2212x1659 · FOV: 45 degrees: 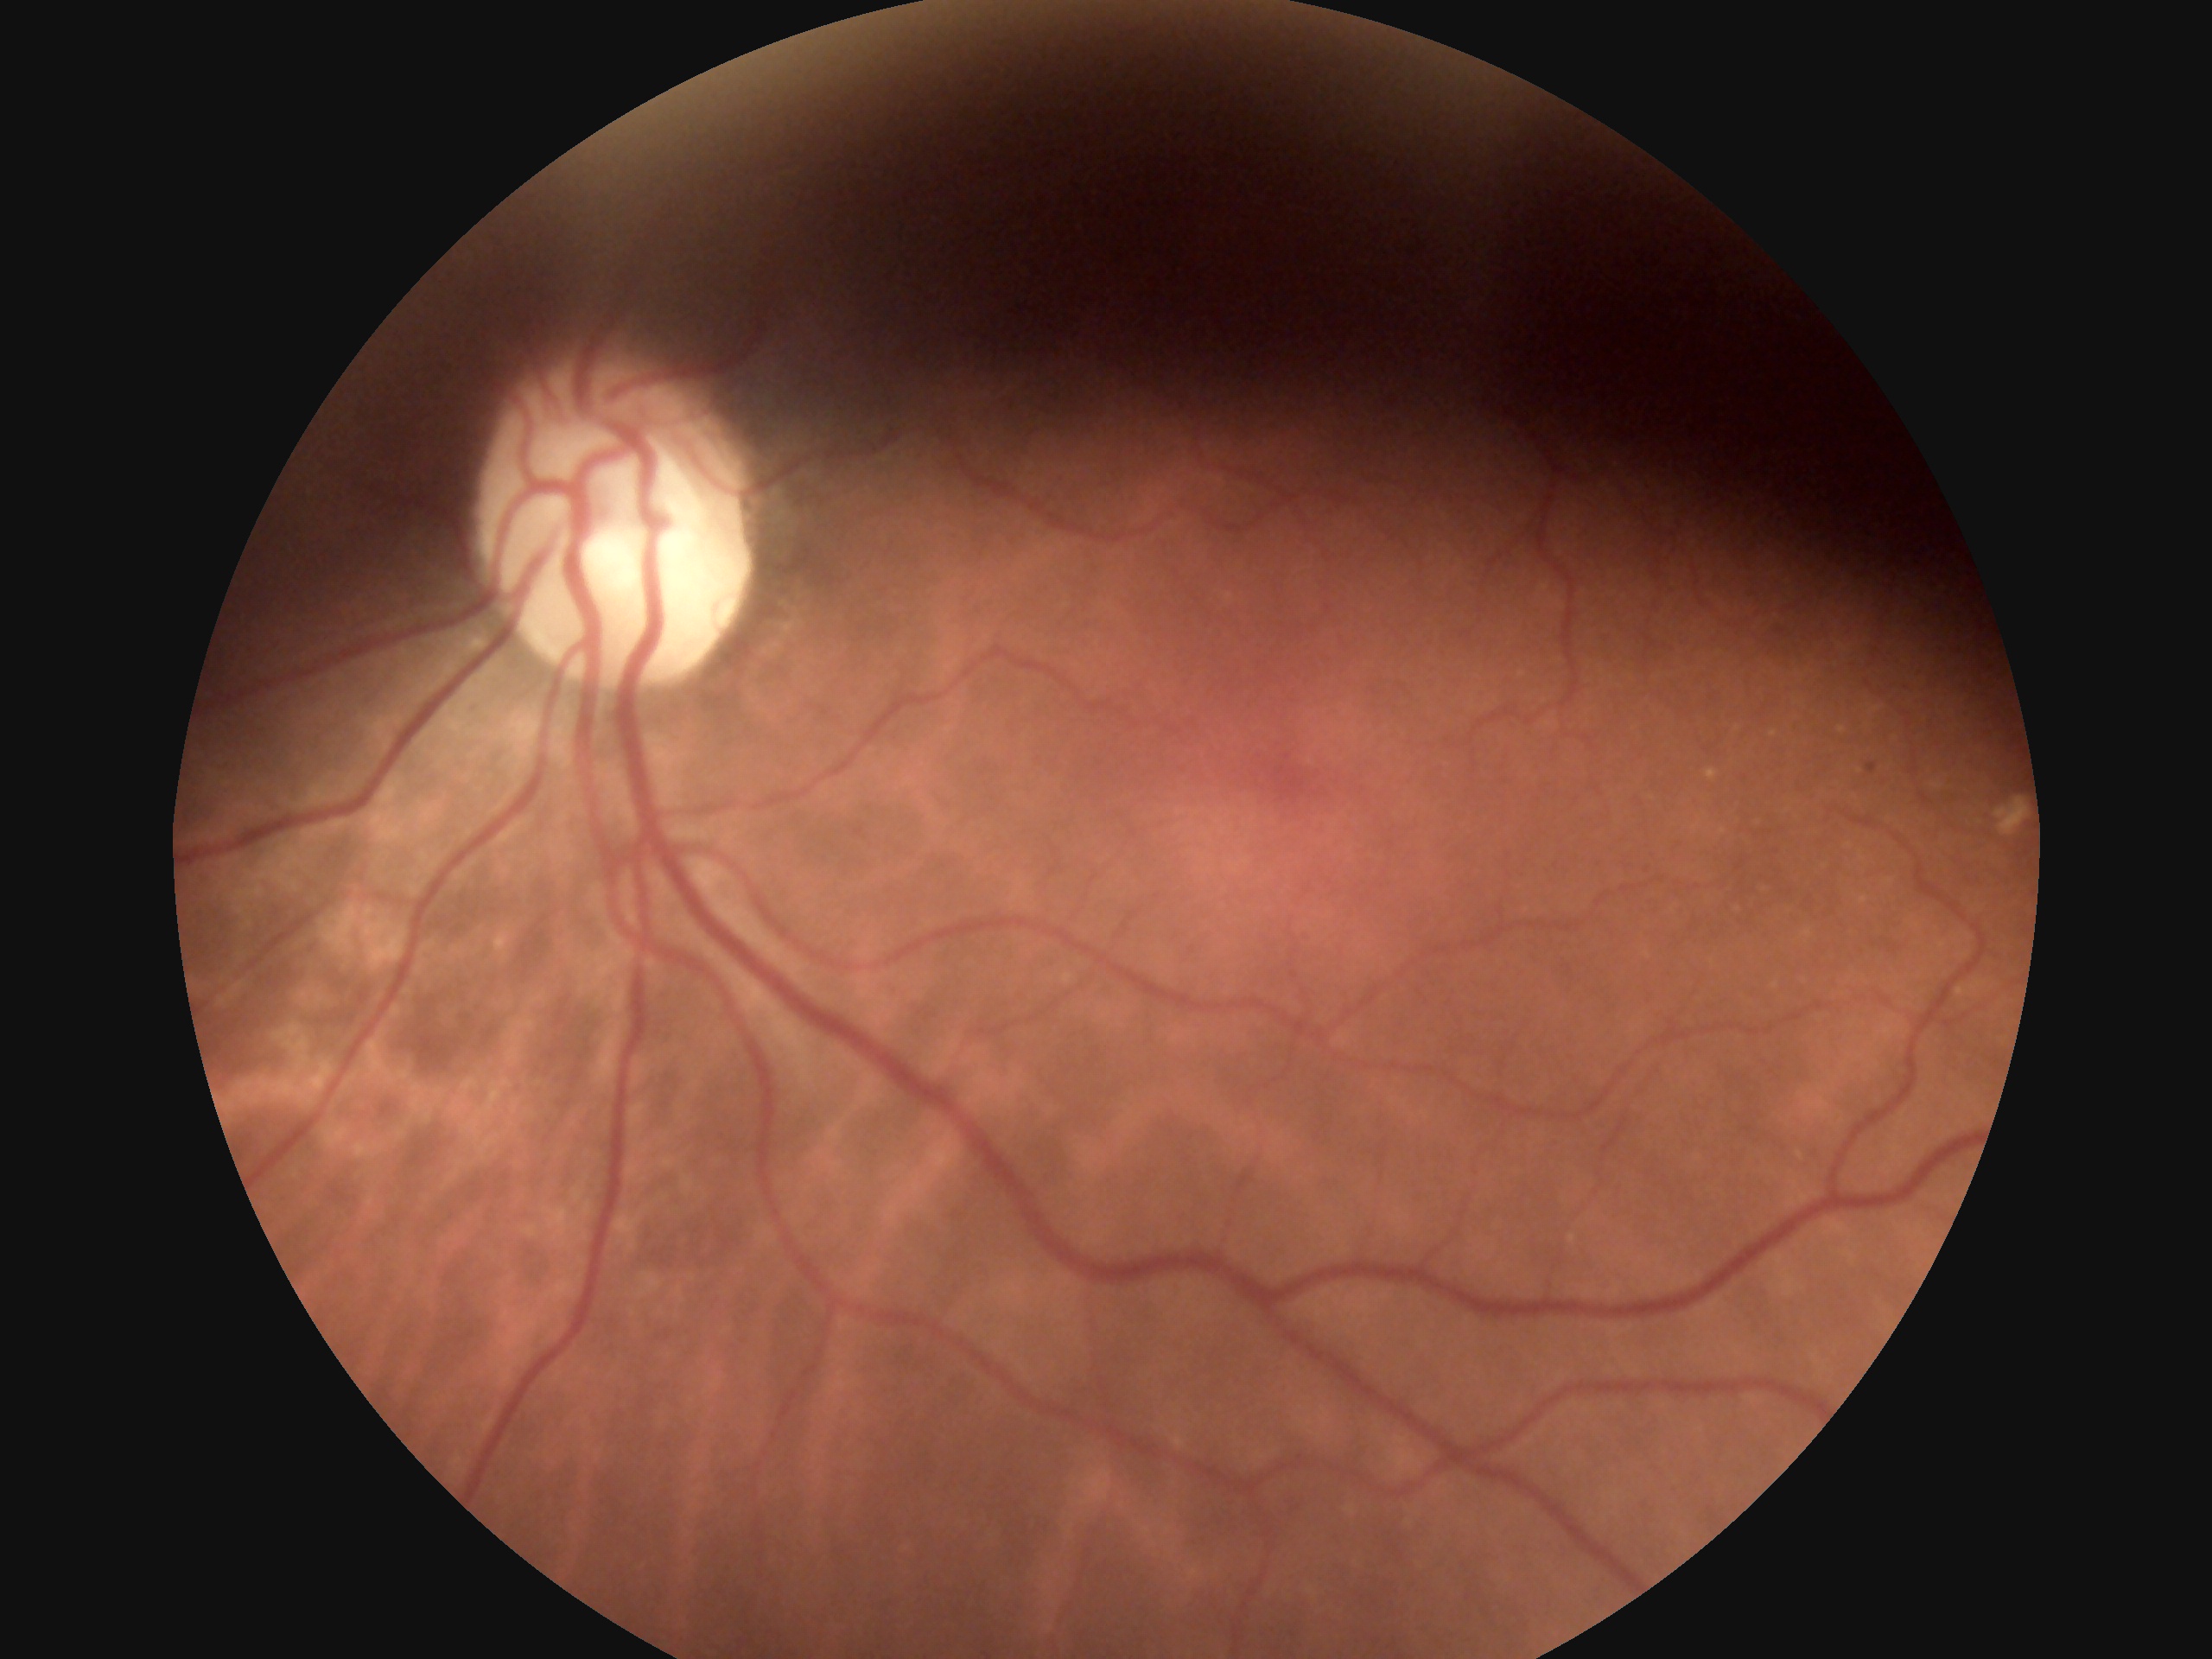
{
  "dr_impression": "no signs of DR",
  "dr_grade": "no apparent diabetic retinopathy (0) — no visible signs of diabetic retinopathy"
}